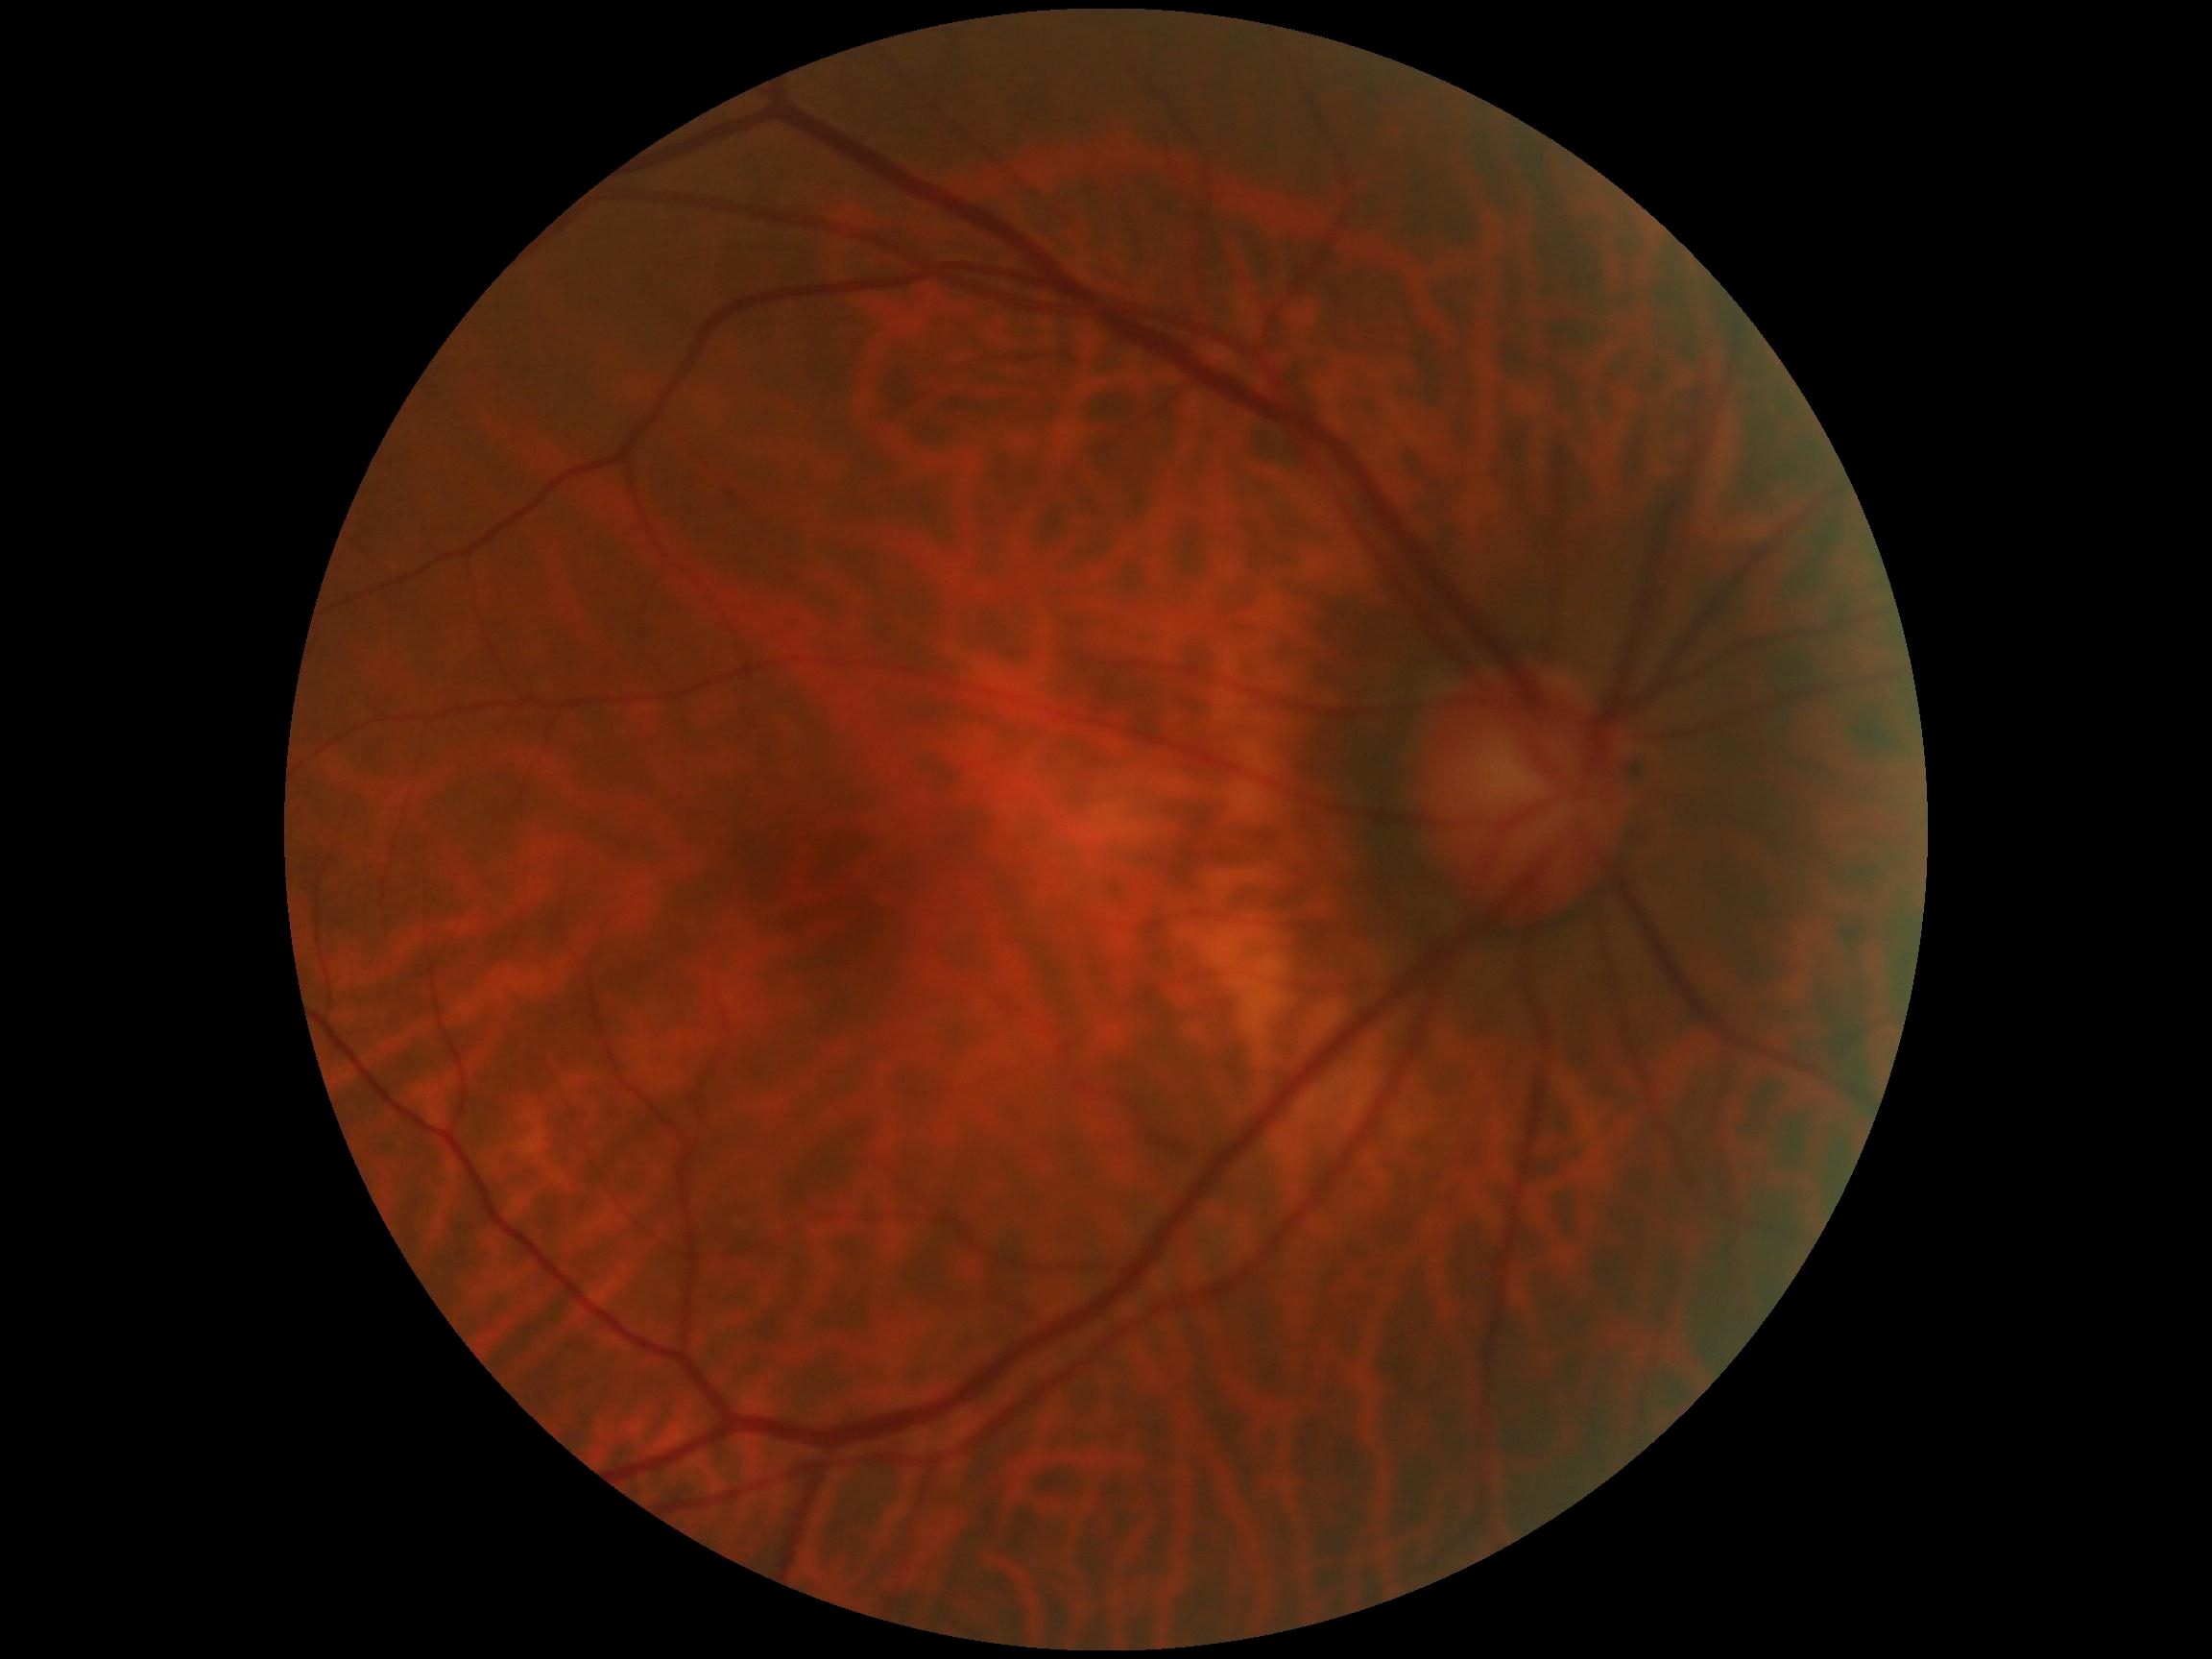
Findings:
* DR — grade 0 (no apparent retinopathy)
* DR impression — no signs of DR